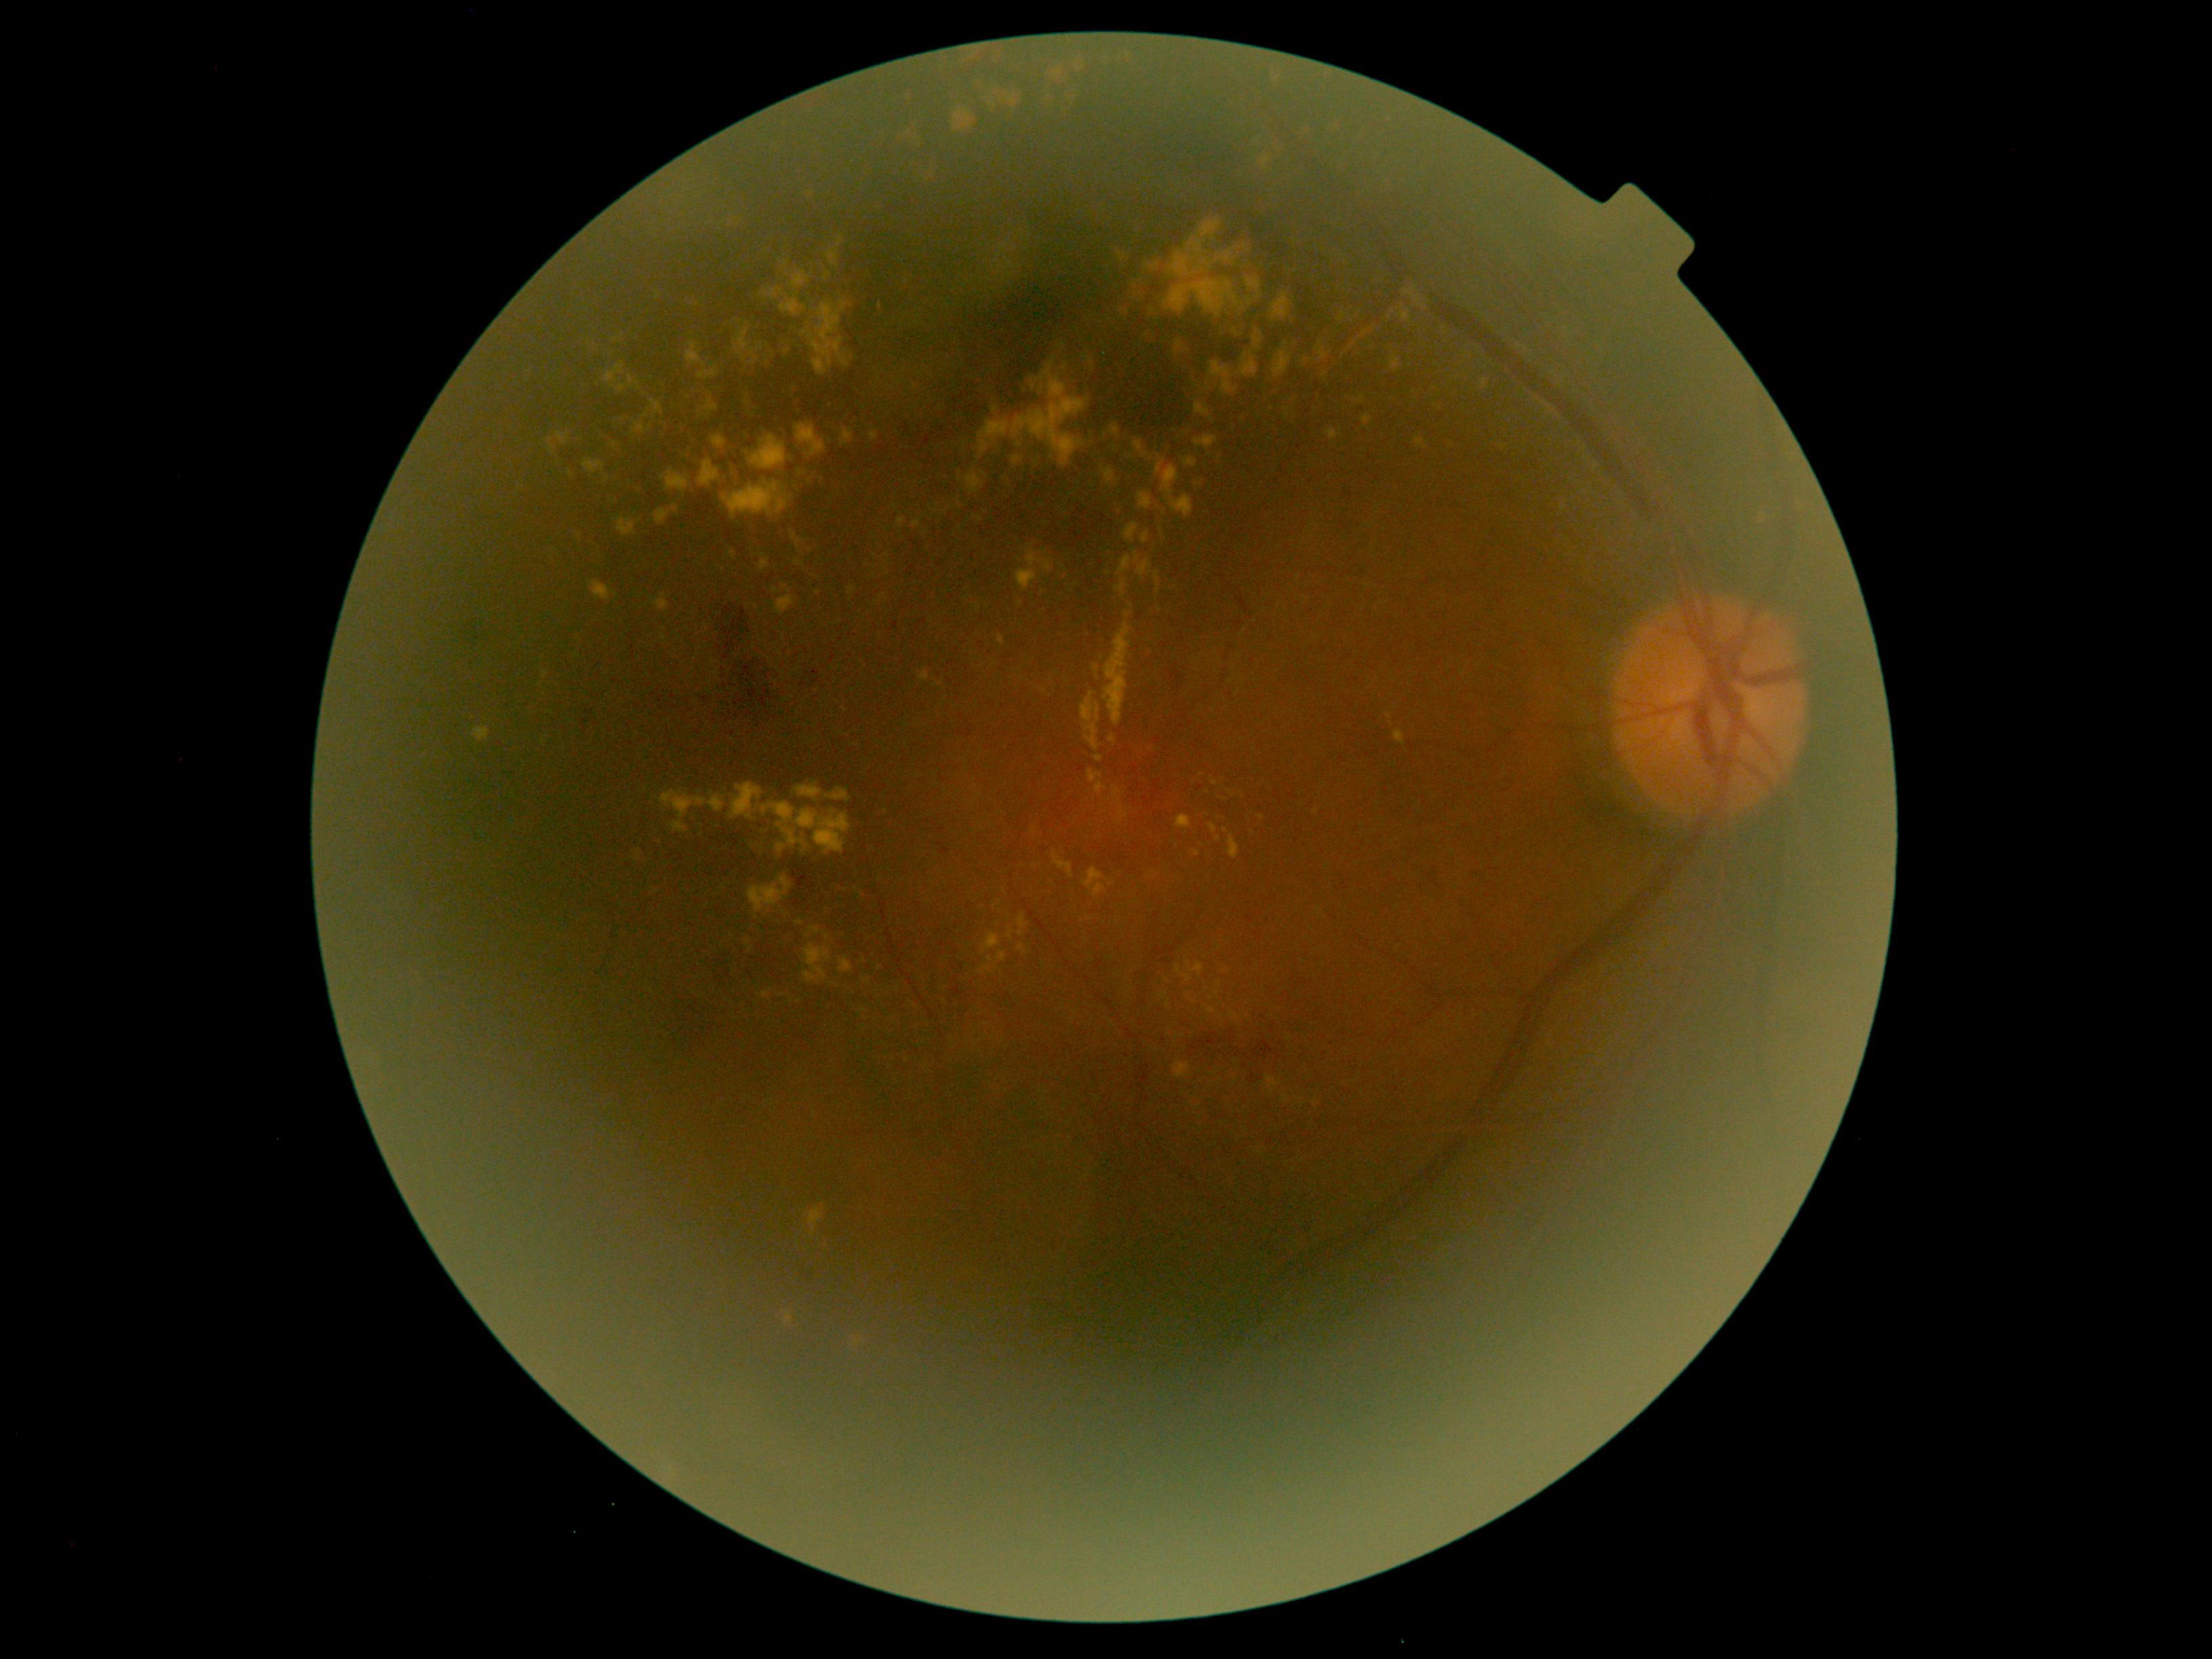
Diabetic retinopathy (DR): 2
Lesions identified (partial list):
hard exudates (EXs) (subset): <region>1088, 769, 1108, 795</region>; <region>583, 459, 607, 475</region>; <region>547, 438, 555, 453</region>; <region>1210, 822, 1218, 834</region>; <region>1338, 314, 1348, 322</region>; <region>795, 560, 806, 566</region>; <region>840, 958, 853, 974</region>; <region>661, 468, 692, 491</region>; <region>990, 234, 1019, 300</region>; <region>1124, 523, 1139, 541</region>; <region>1399, 307, 1412, 322</region>; <region>796, 920, 804, 925</region>
EXs (small, approximate centers) near [x=676, y=633]; [x=787, y=351]; [x=579, y=534]; [x=732, y=554]; [x=1199, y=1106]; [x=1021, y=603]; [x=983, y=473]